Wide-field fundus image from infant ROP screening. 640 by 480 pixels
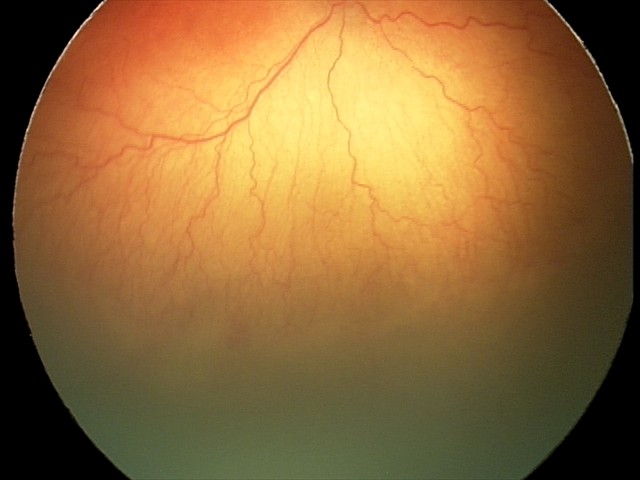

Plus disease: present, diagnosis: aggressive retinopathy of prematurity (A-ROP).